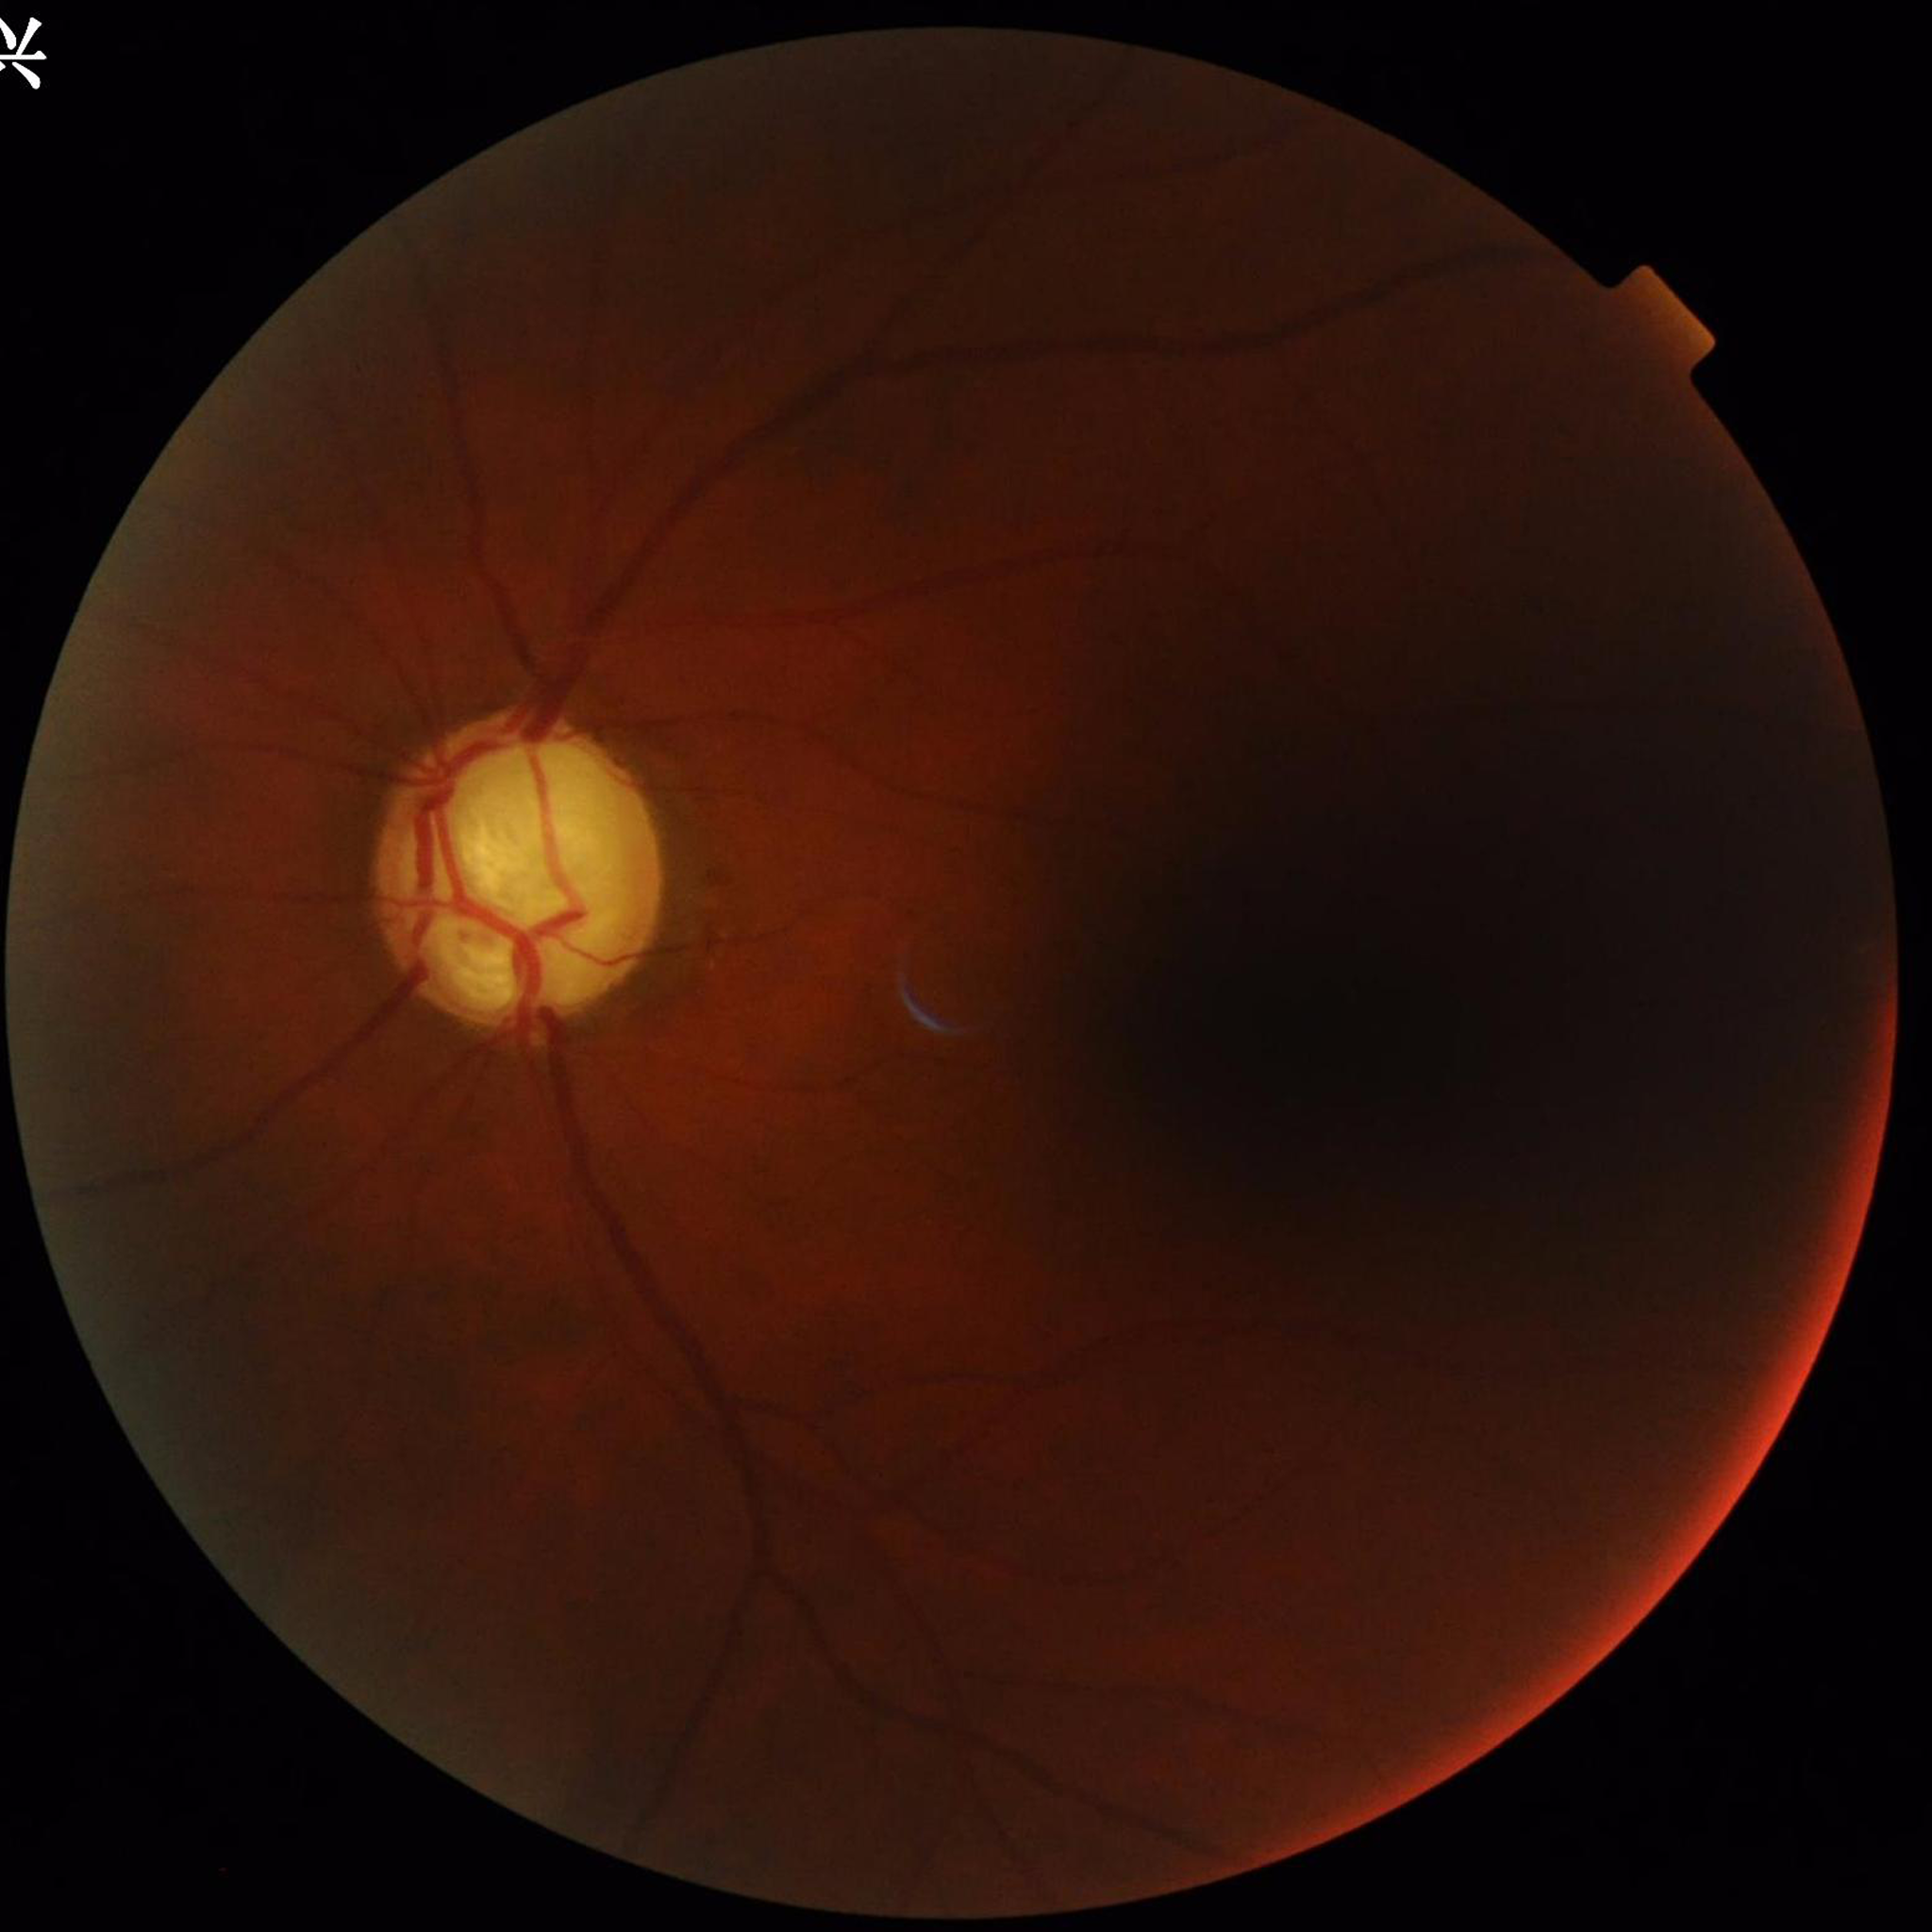
Clinical diagnosis: glaucoma
Quality assessment: issues noted — illumination/color distortion, blur